Image size 2352x1568 · 45-degree field of view · color fundus image: 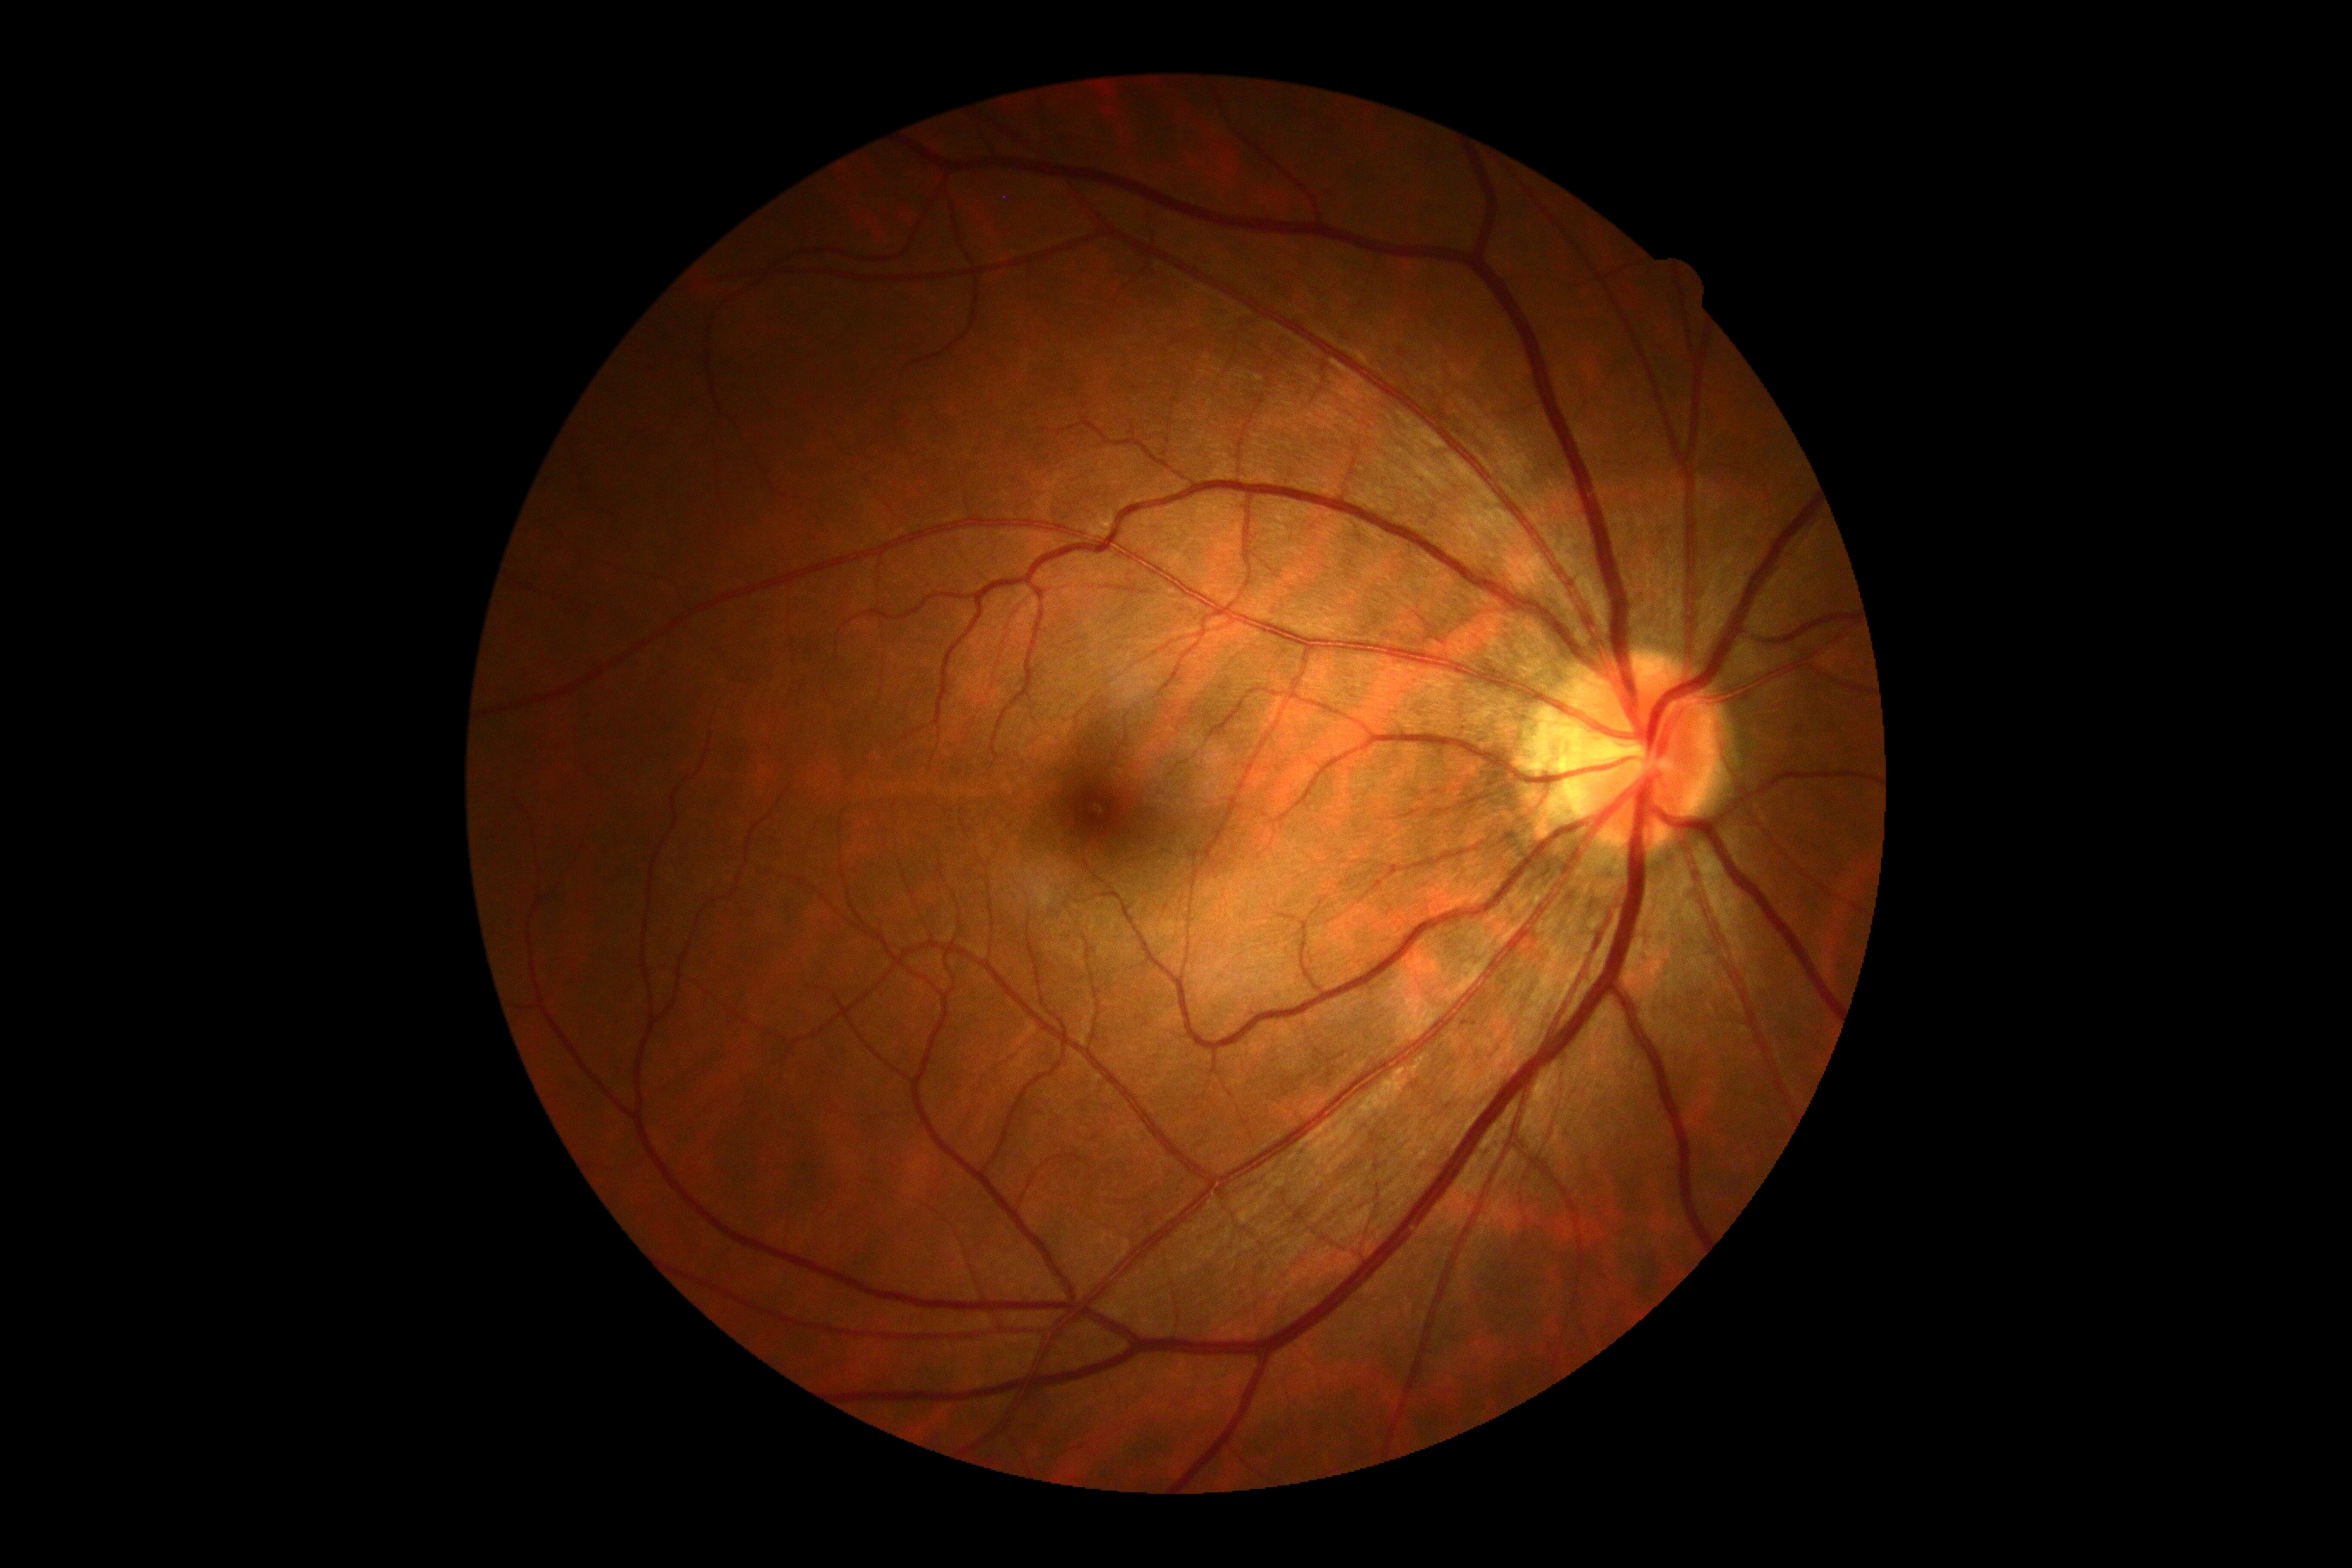
DR severity: no apparent retinopathy (grade 0).